Color fundus photograph, image size 412x310.
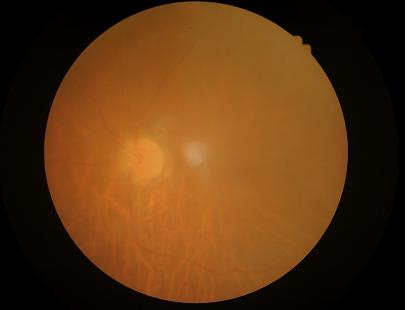

Contrast = low, vessels and details hard to distinguish; Illumination = uniform, no color cast; Focus = reduced sharpness with visible blur; Overall = poor, ungradable.